CFP.
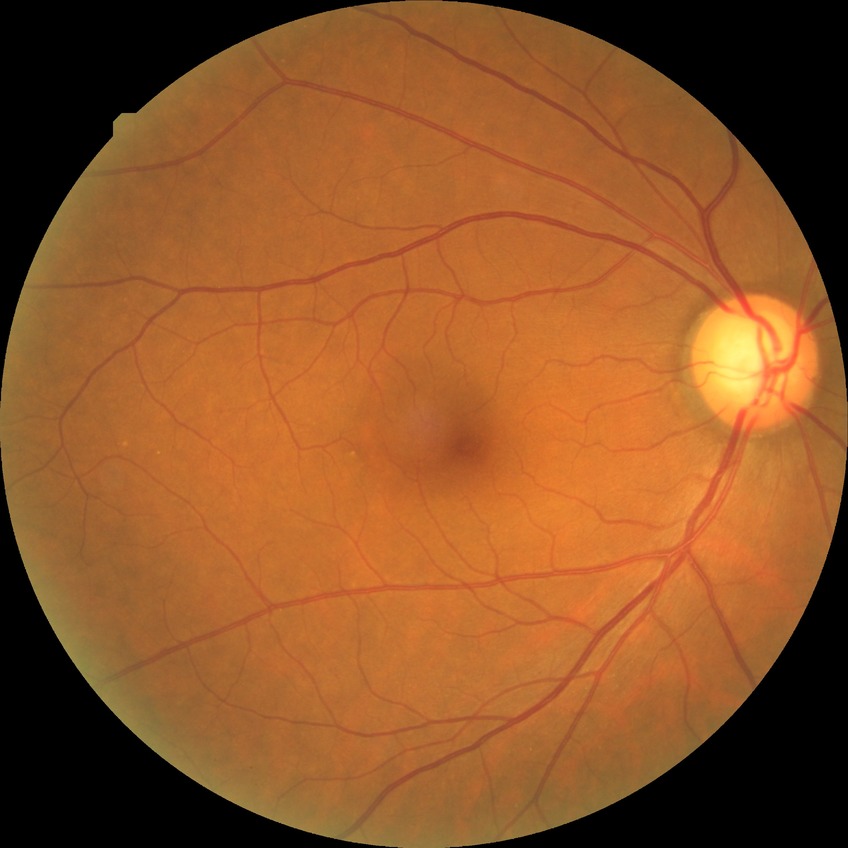 Diabetic retinopathy (DR): NDR (no diabetic retinopathy).